848 x 848 pixels:
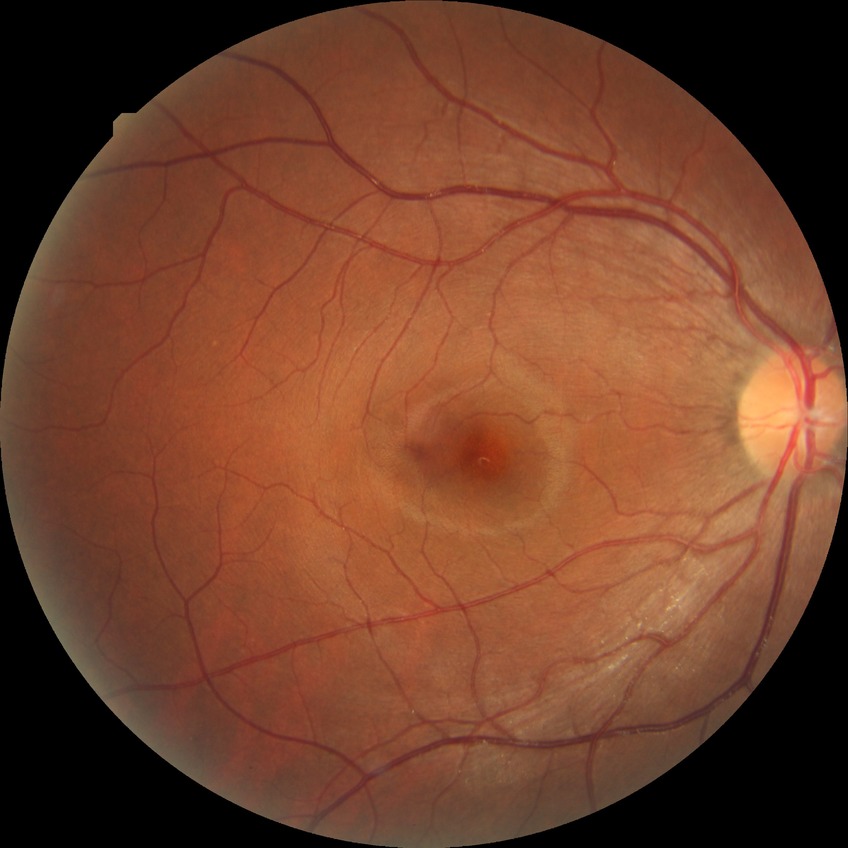

Diabetic retinopathy severity: no diabetic retinopathy.